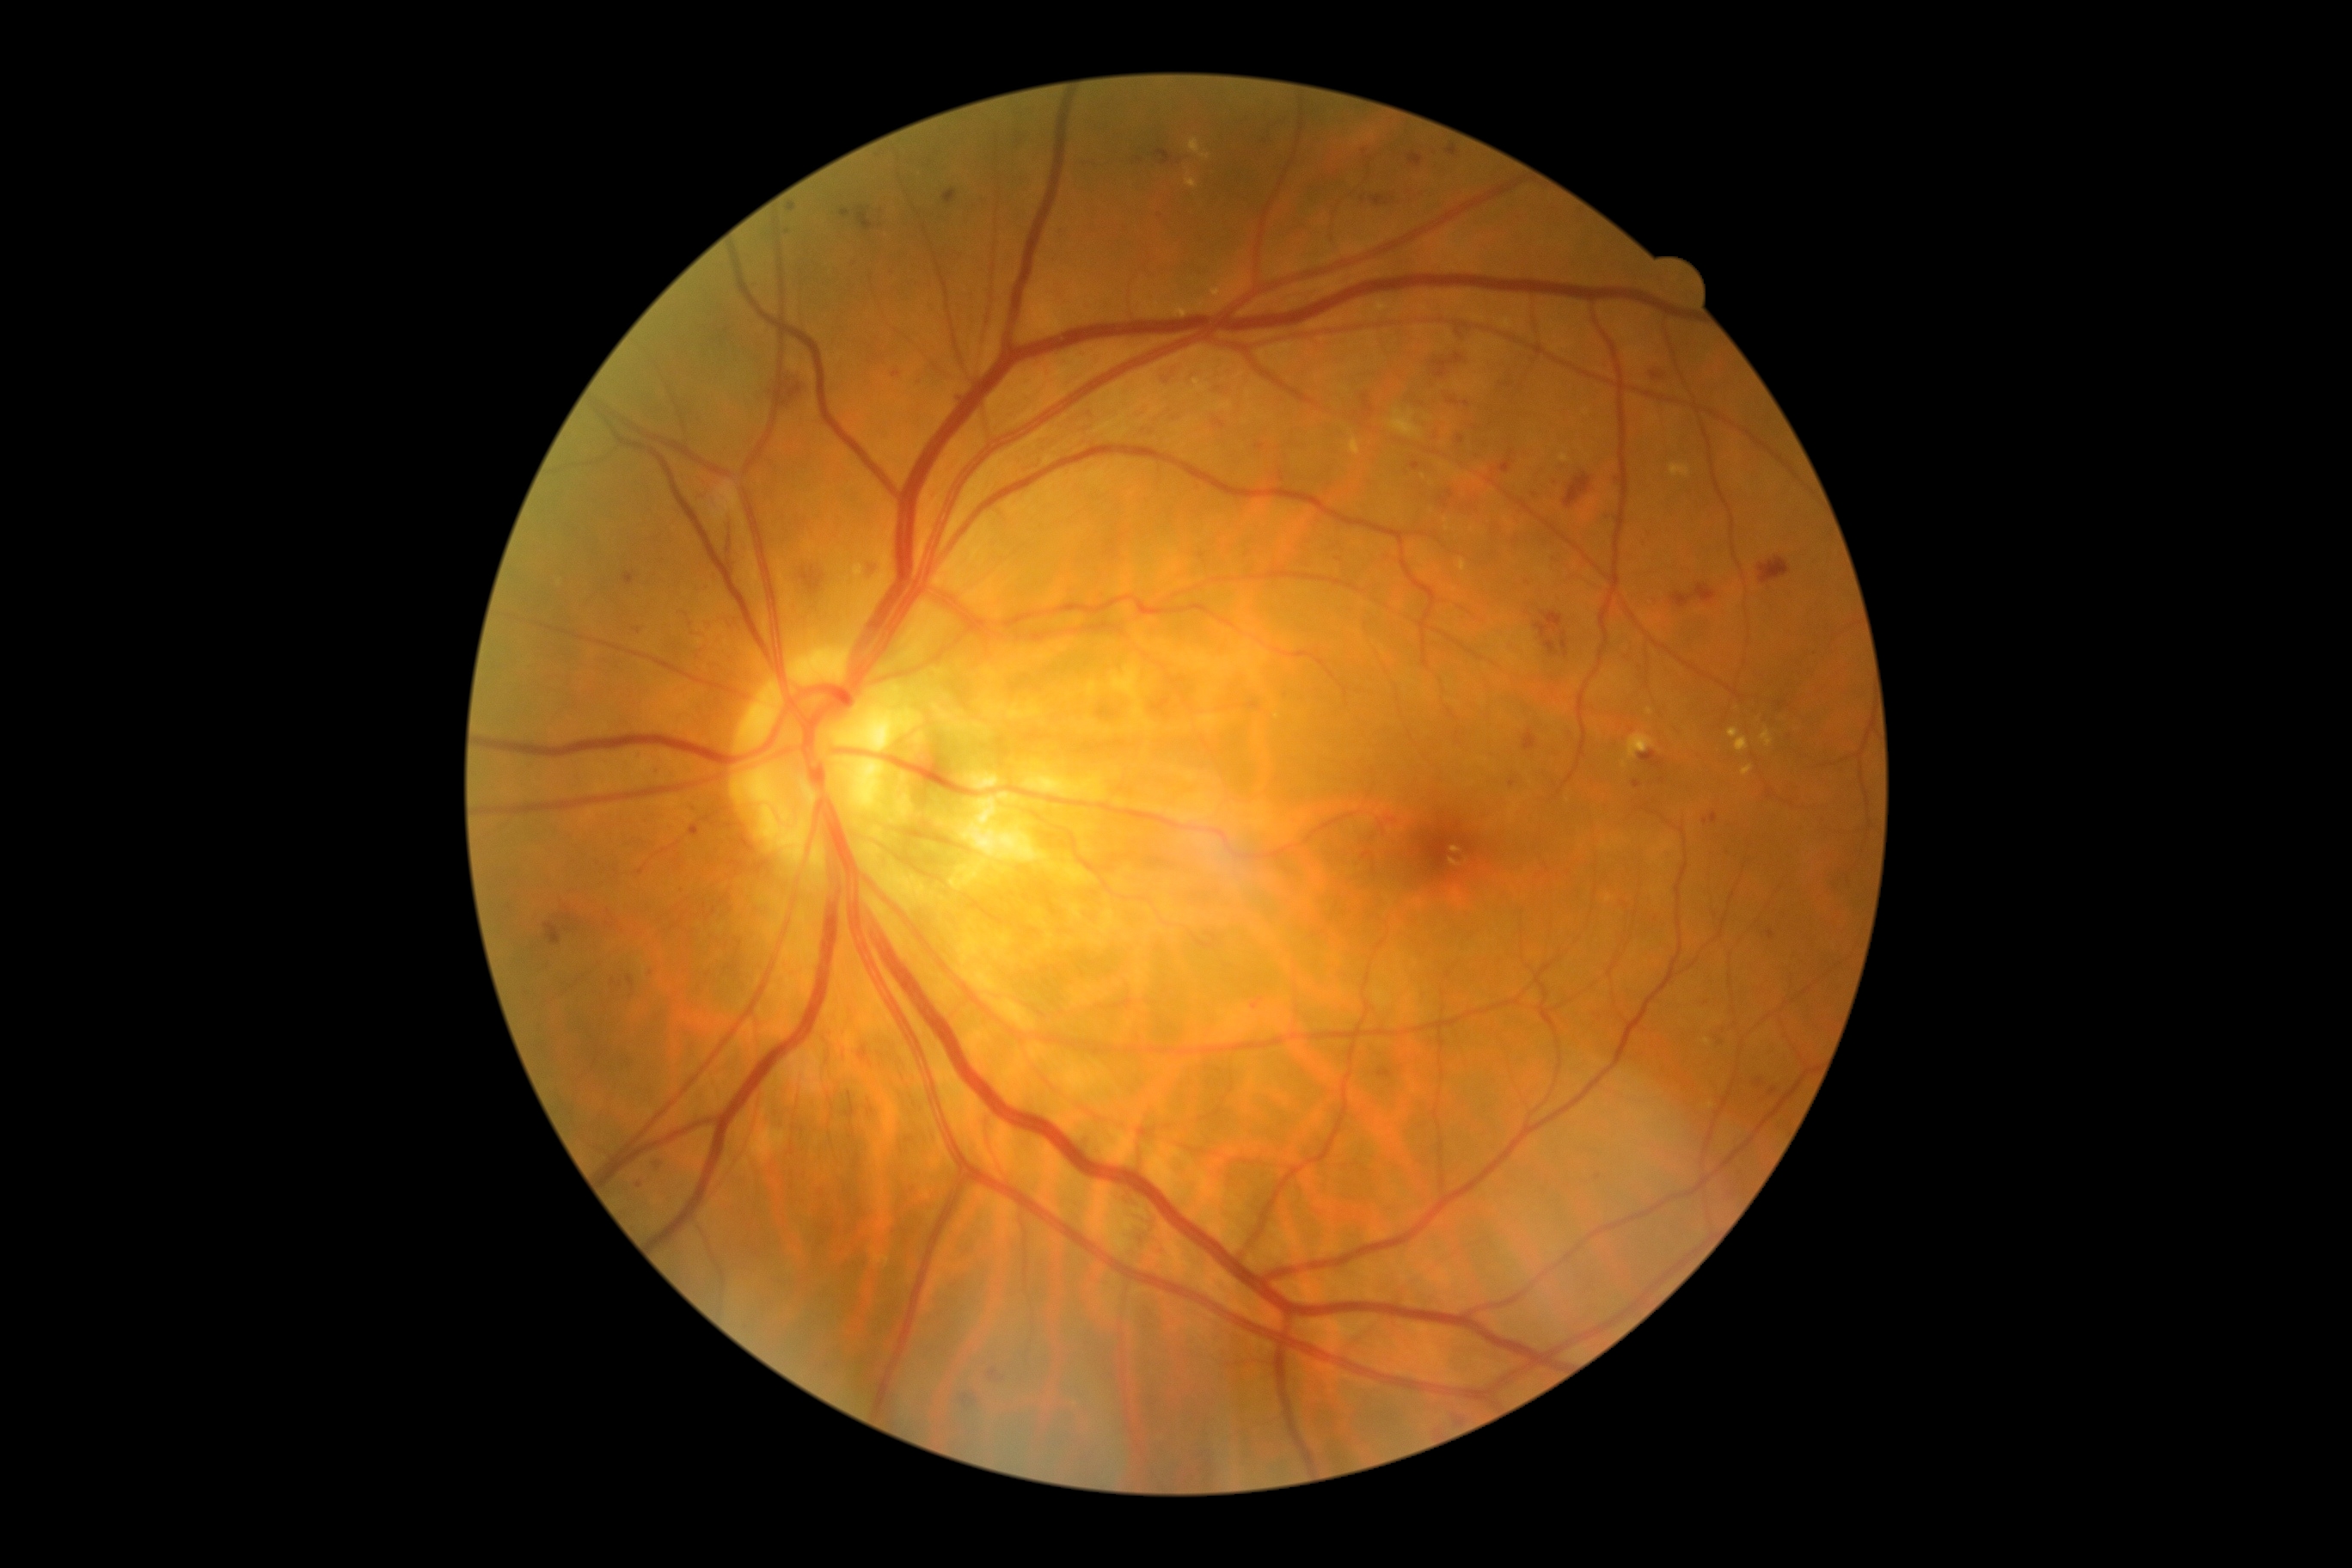 partial: true
dr_grade: 2
dr_grade_name: moderate NPDR
lesions:
  se:
    - (1390, 410, 1423, 439)
  ma:
    - (627, 976, 635, 989)
    - (943, 190, 959, 205)
    - (1560, 632, 1569, 659)
    - (695, 496, 704, 503)
    - (1632, 781, 1641, 788)
    - (1524, 582, 1533, 591)
    - (1163, 377, 1173, 391)
    - (1447, 398, 1461, 405)
    - (1534, 611, 1564, 640)
    - (1498, 451, 1514, 474)
    - (1412, 463, 1421, 470)
    - (637, 754, 642, 763)
  ma_small_centers:
    - (1705,822)
    - (708,630)
    - (917,384)
    - (1139,160)
    - (1760,1083)
    - (1728,857)
    - (639,1186)
  he:
    - (1522, 728, 1538, 750)
    - (802, 568, 826, 596)
    - (1672, 584, 1718, 609)
    - (544, 924, 561, 946)
    - (1433, 355, 1464, 379)
    - (1565, 474, 1593, 508)
    - (1758, 558, 1791, 585)
    - (859, 1048, 873, 1067)
    - (1452, 324, 1469, 345)
    - (780, 372, 809, 413)
    - (726, 522, 737, 560)
    - (869, 563, 883, 582)
  ex:
    - (1559, 455, 1569, 463)
    - (1349, 438, 1361, 456)
    - (1185, 178, 1197, 188)
    - (1741, 766, 1753, 776)
    - (1450, 847, 1461, 854)
    - (1736, 737, 1749, 752)
    - (1173, 274, 1247, 319)
    - (1191, 138, 1210, 161)
  ex_small_centers:
    - (1423,477)
    - (1624,766)
    - (1472,530)
    - (1708,1042)